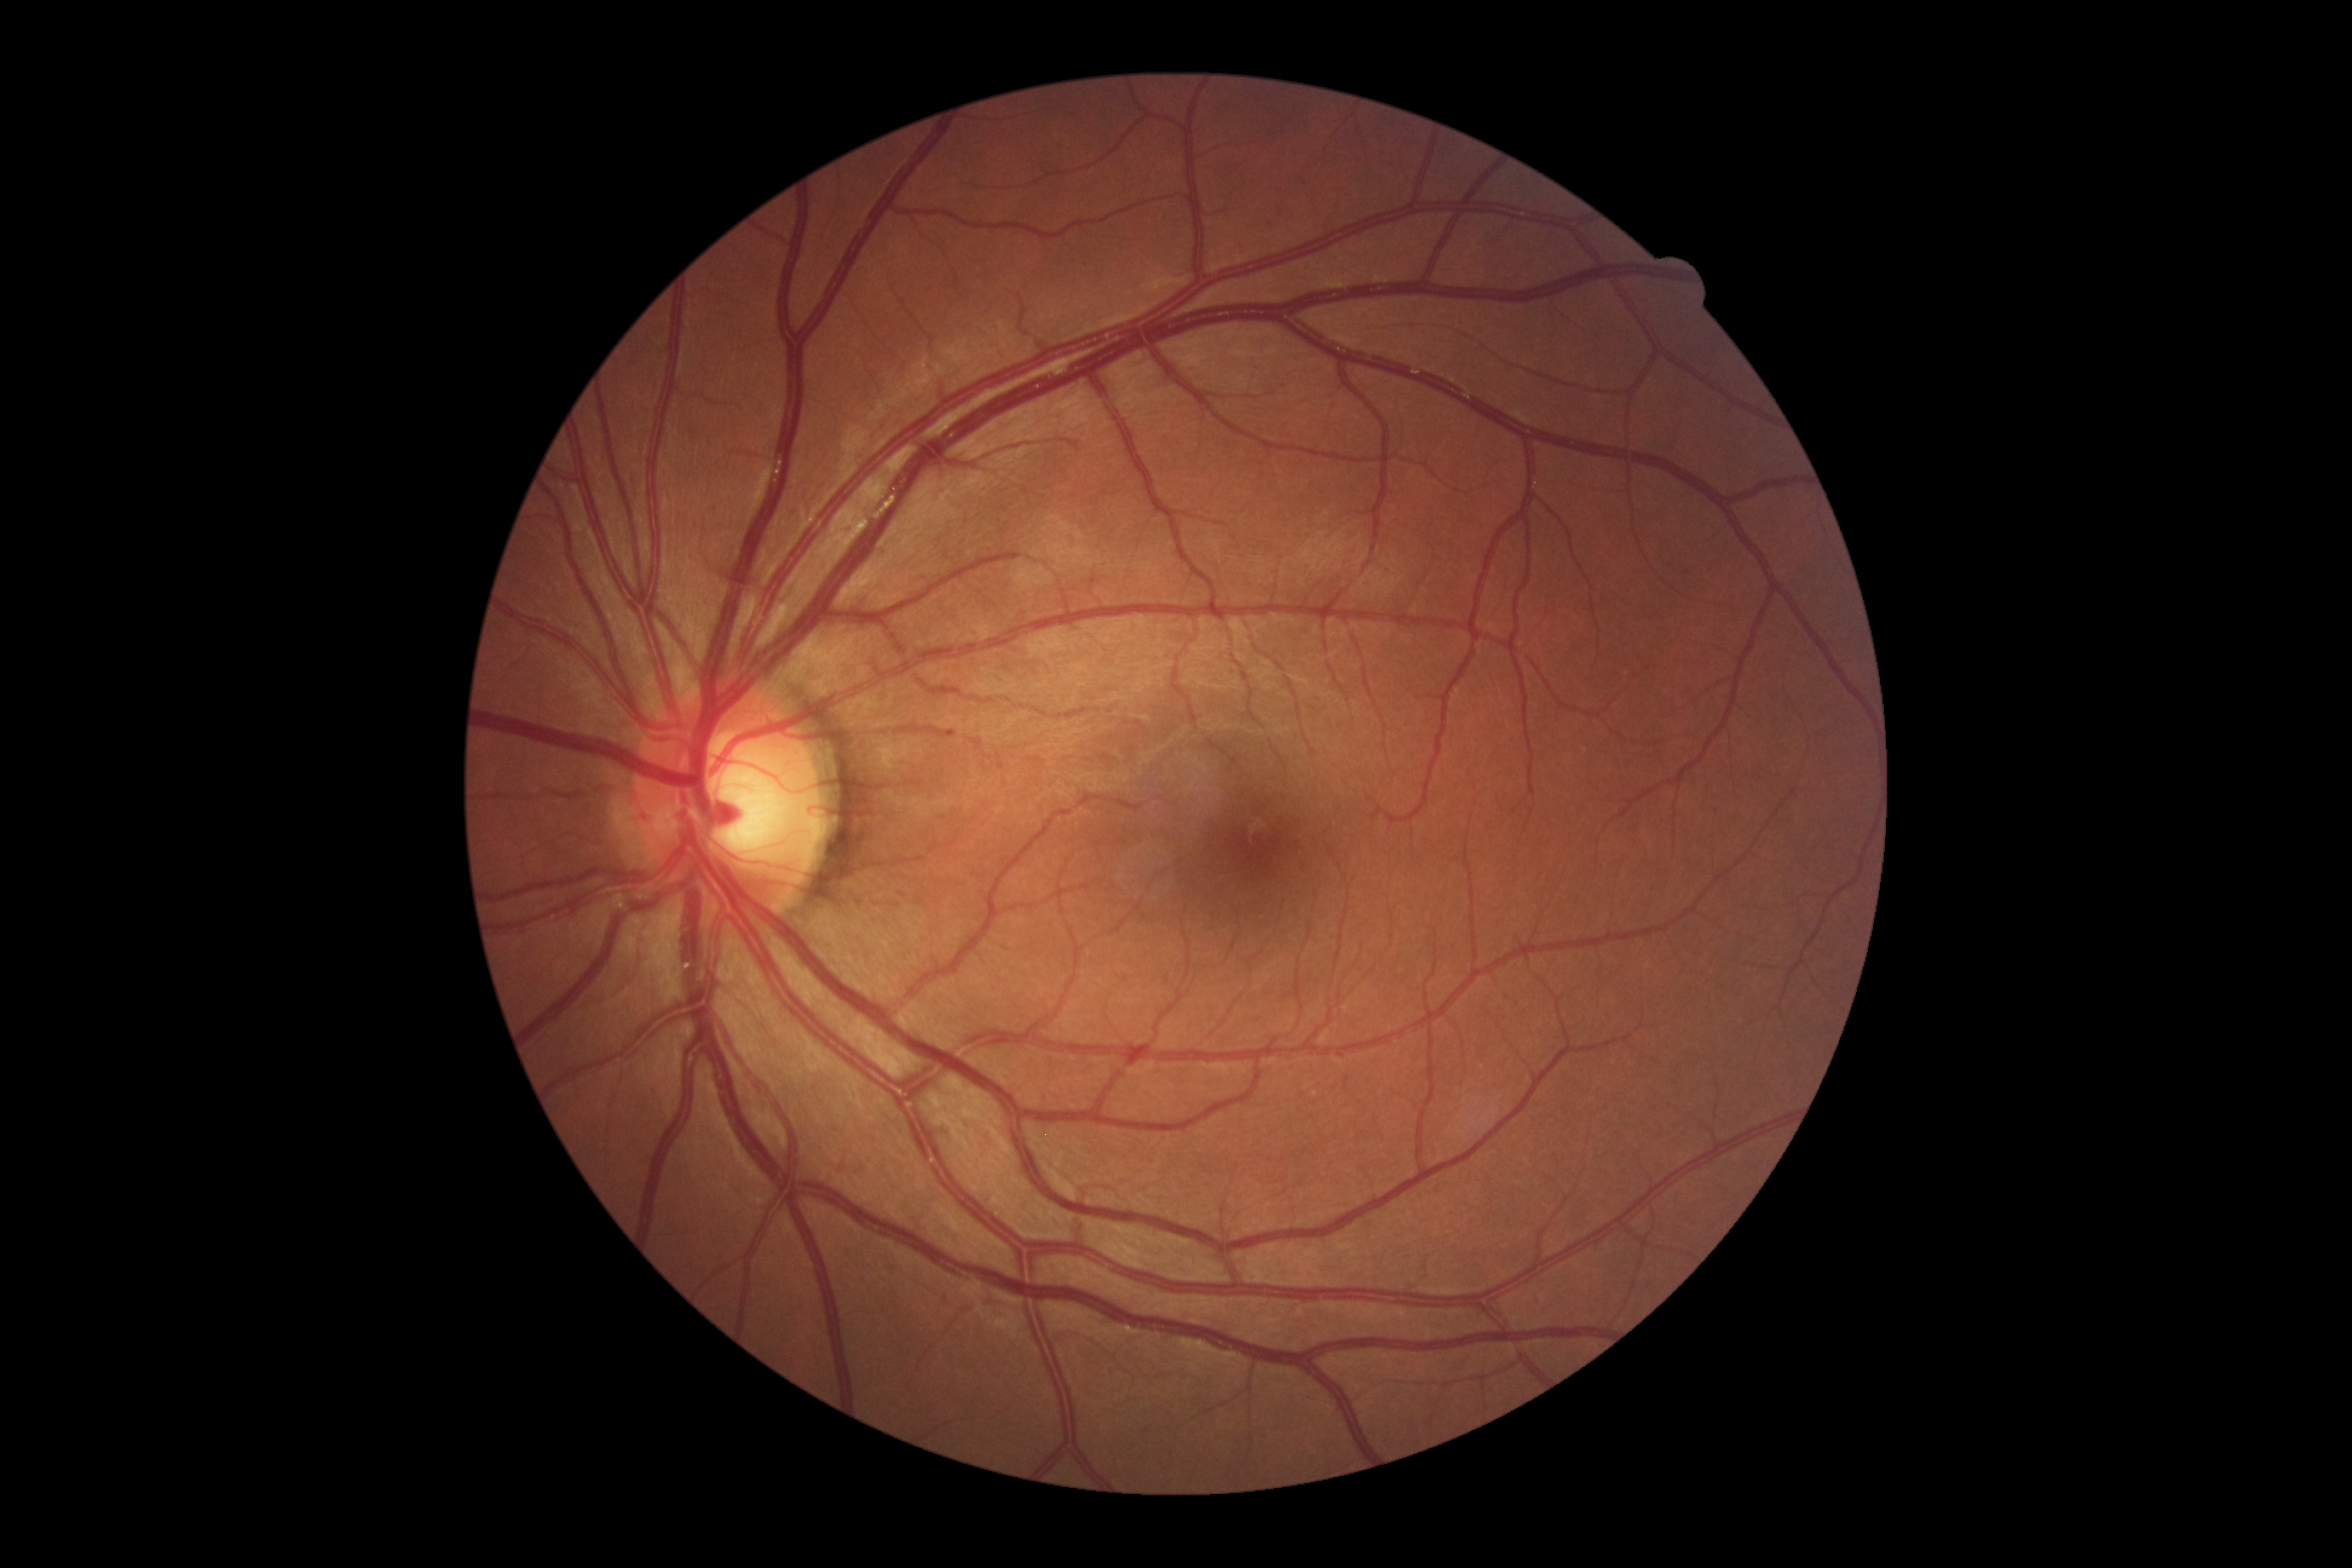

DR grade: 0 (no apparent retinopathy).